Image size 1924x1556; 200-degree field of view; UWF retinal mosaic
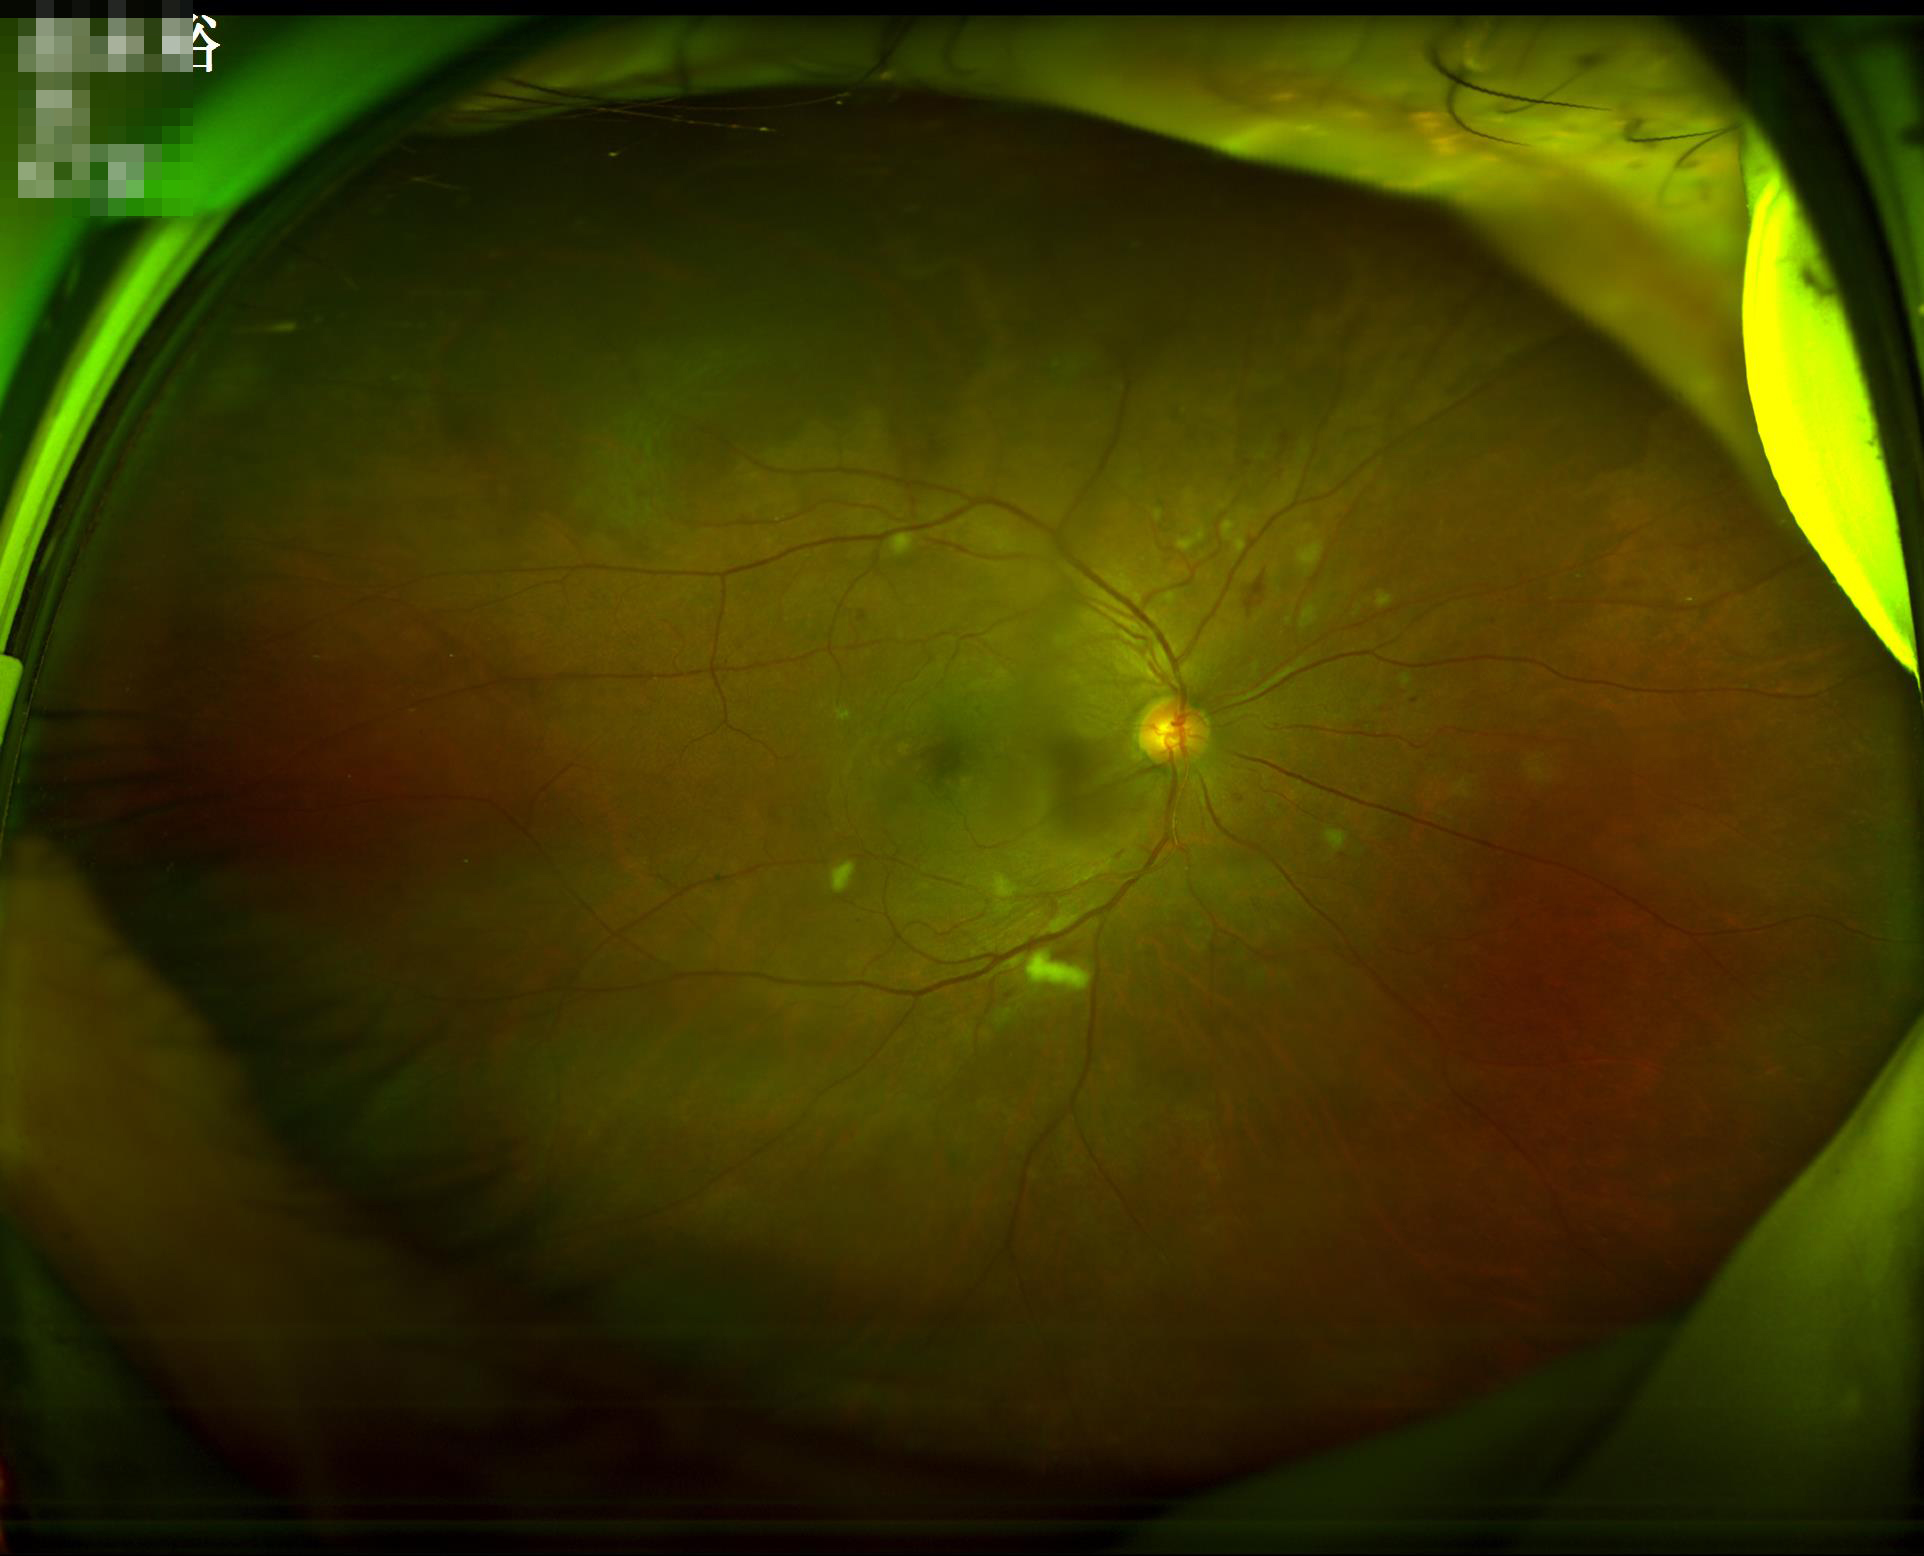 Noticeable blur in the optic disc, vessels, or background.
Overall quality is good and the image is gradable.
Illumination and color balance are good.